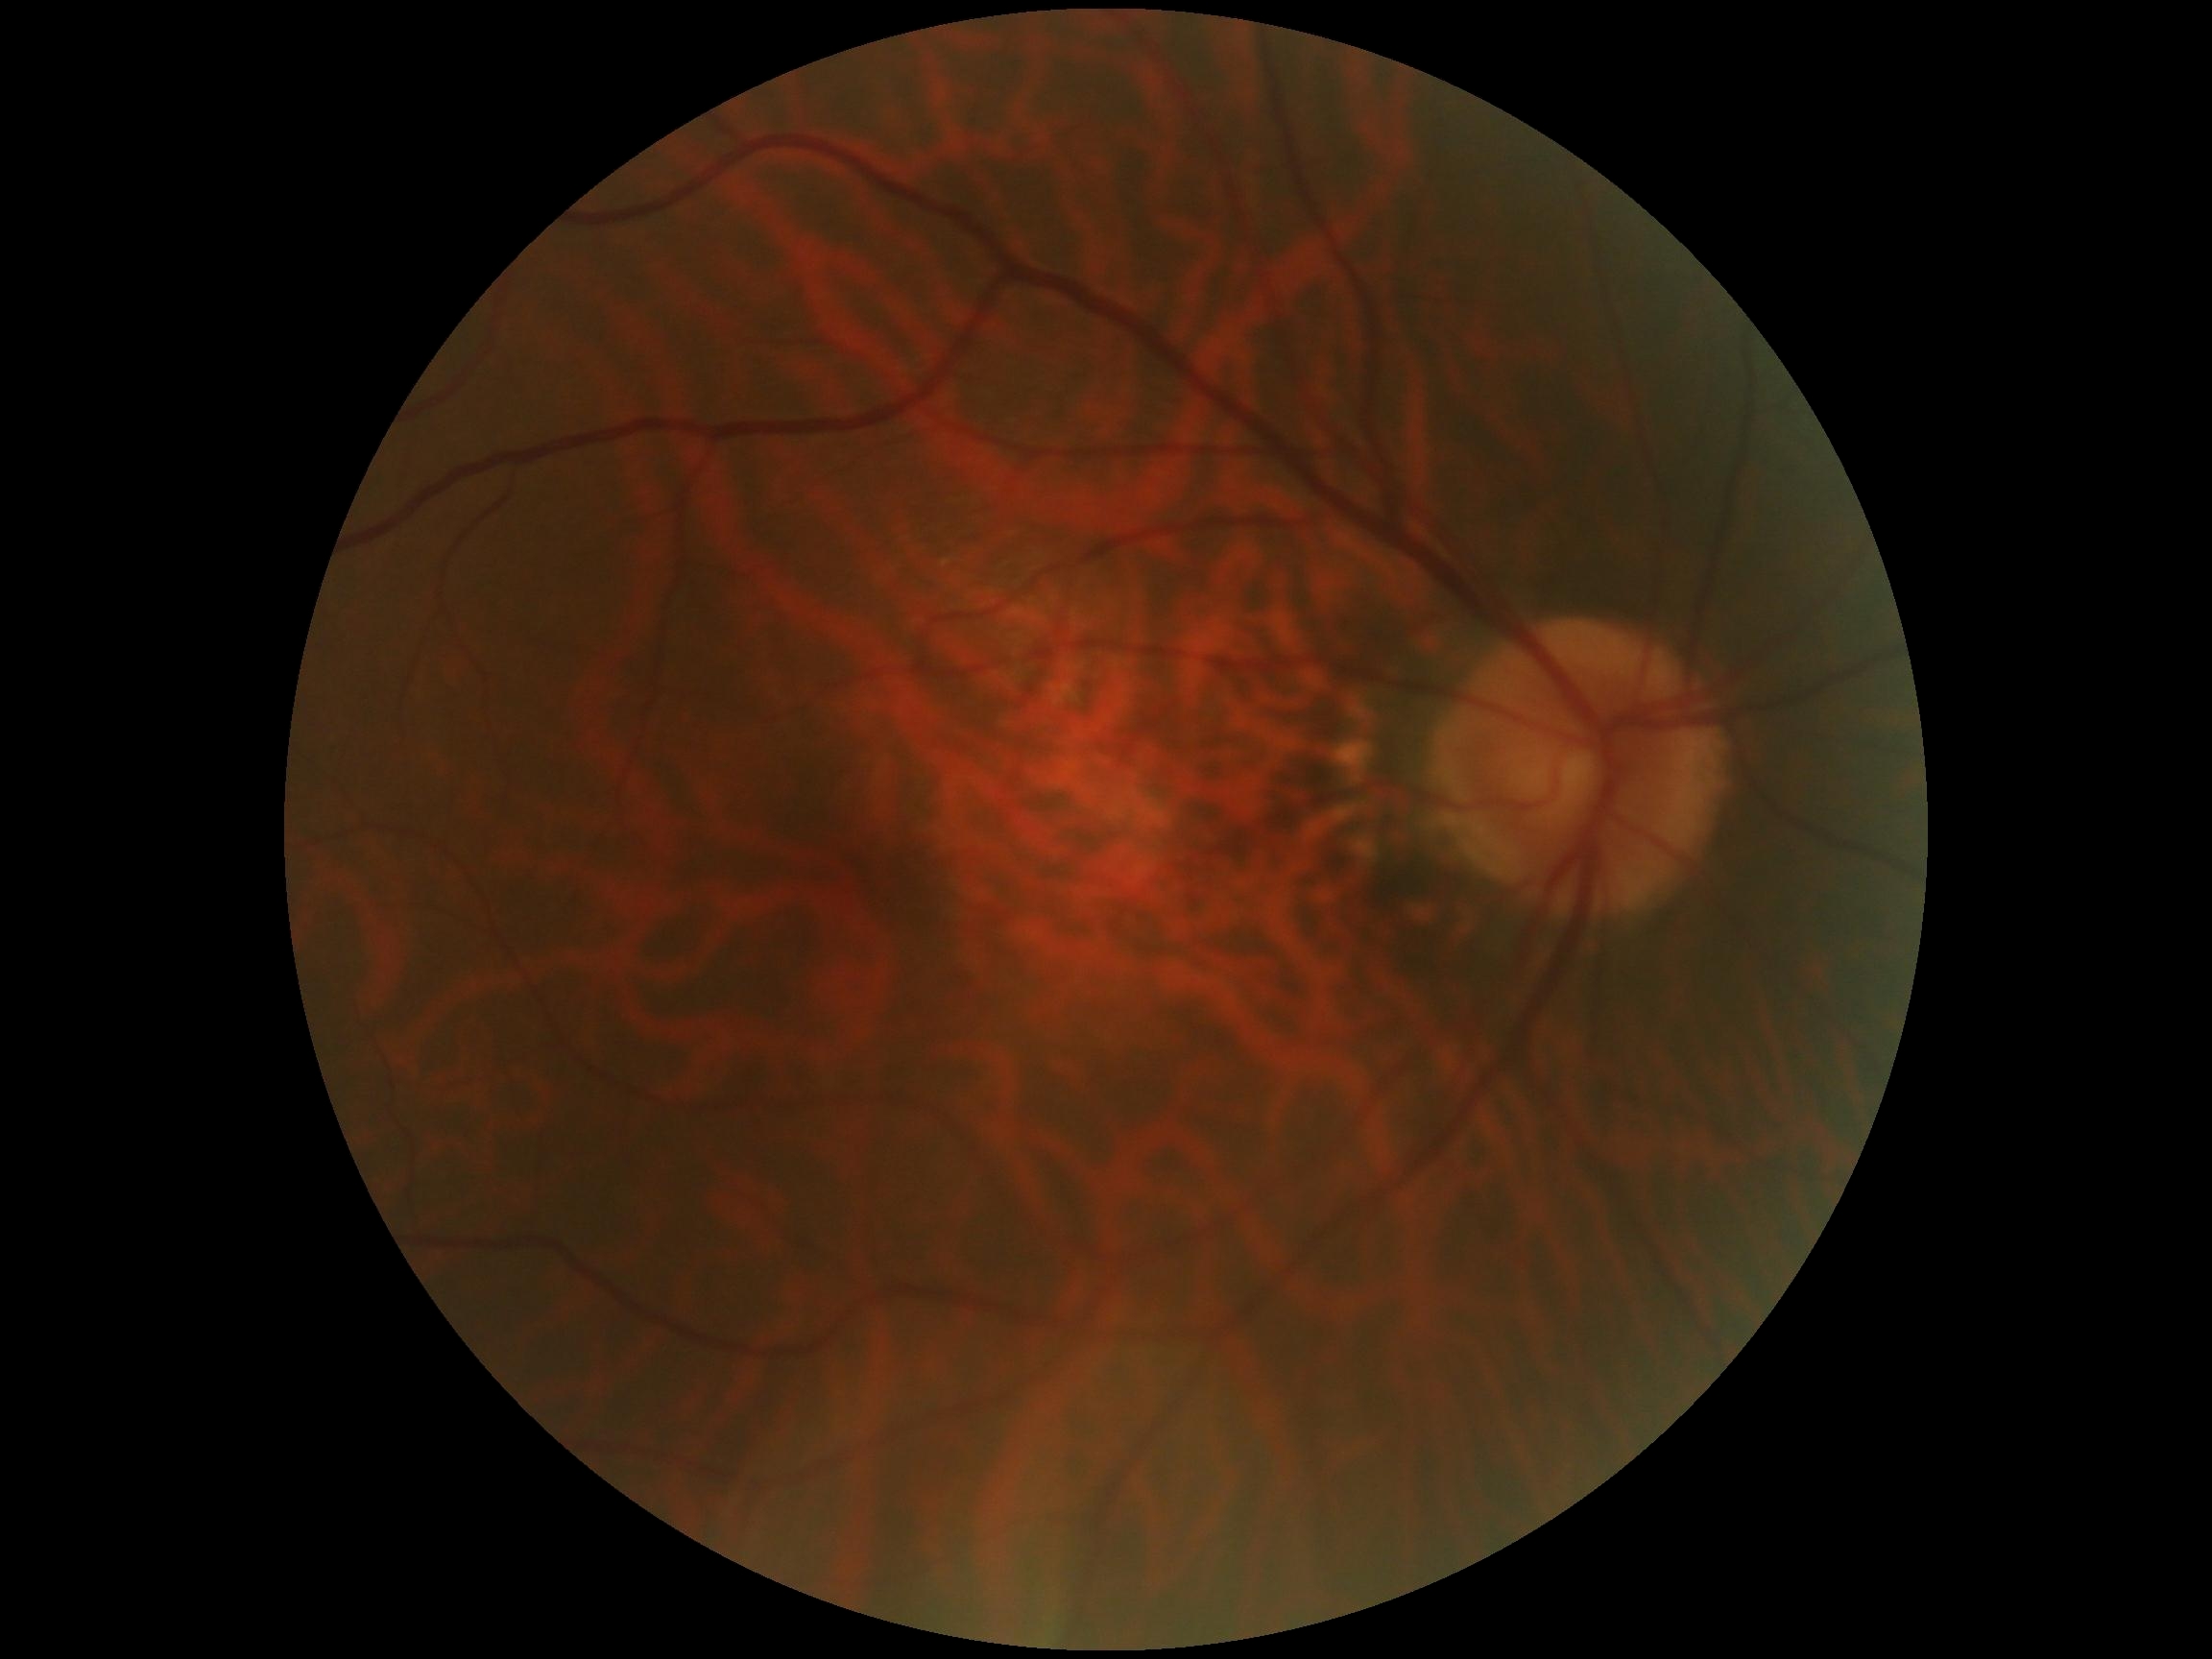 retinopathy grade: no apparent diabetic retinopathy (0) — no visible signs of diabetic retinopathy.